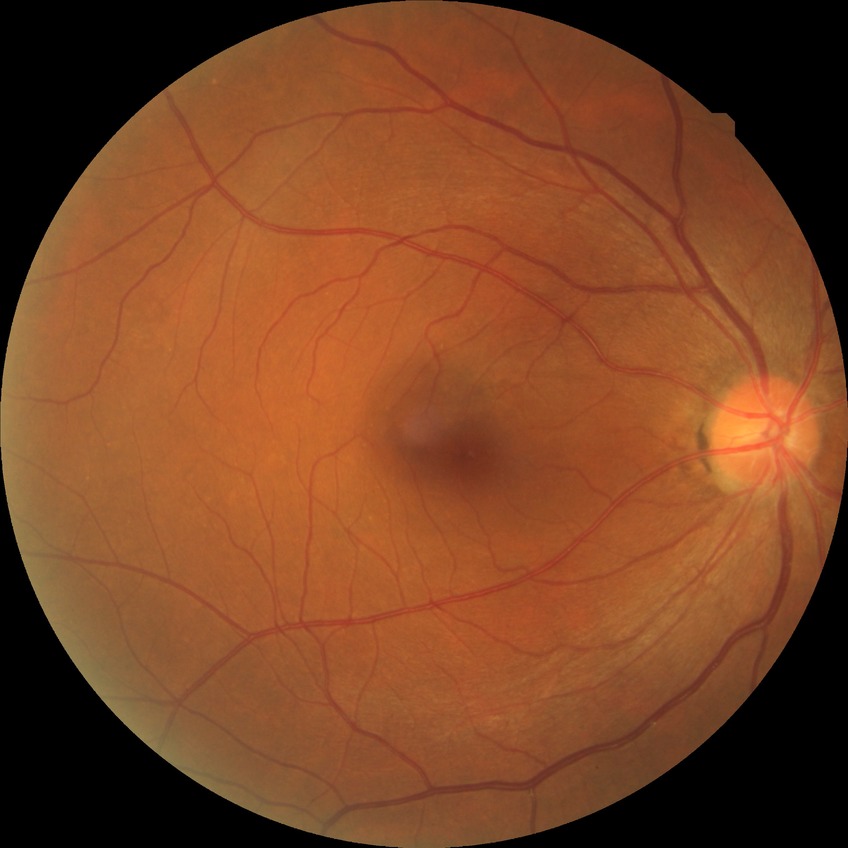

  davis_grade: NDR (no diabetic retinopathy)